45° field of view · 848x848 · NIDEK AFC-230.
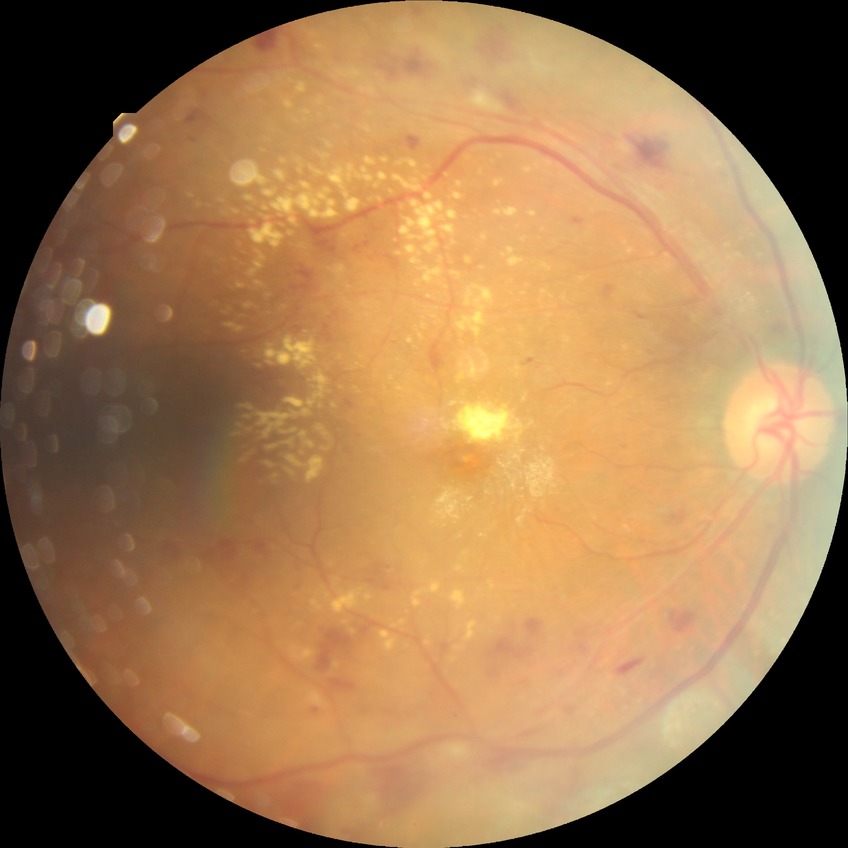

diabetic retinopathy (DR): pre-proliferative diabetic retinopathy (PPDR).